NIDEK AFC-230. 45° field of view. Nonmydriatic fundus photograph. Posterior pole color fundus photograph: 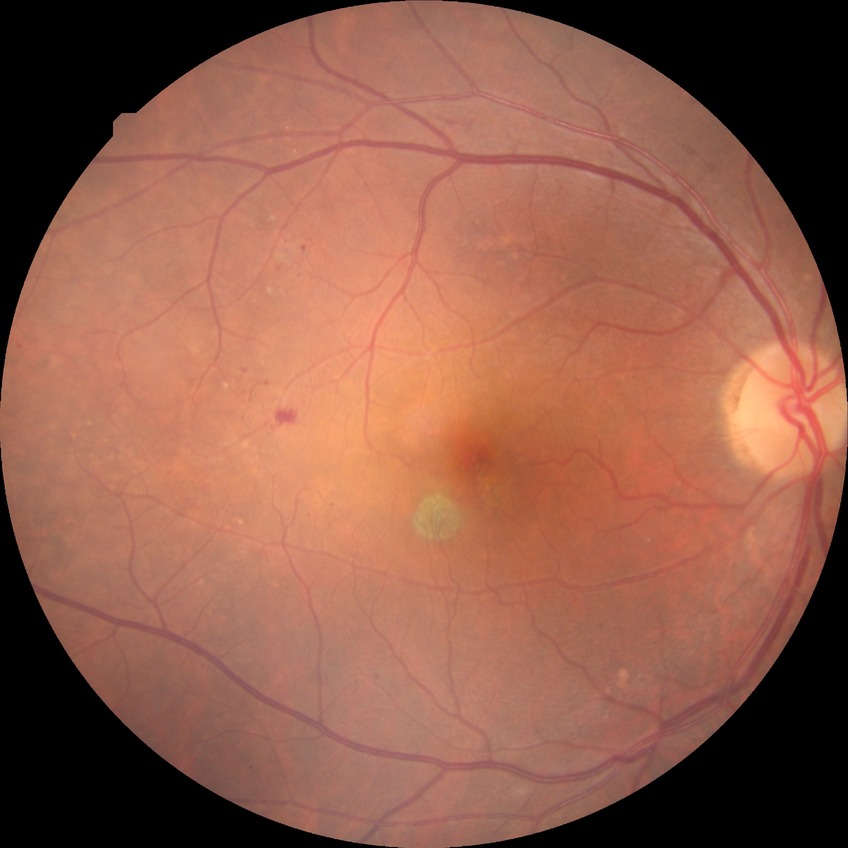   davis_grade: PPDR (pre-proliferative diabetic retinopathy)